45° FOV, posterior pole color fundus photograph, nonmydriatic — 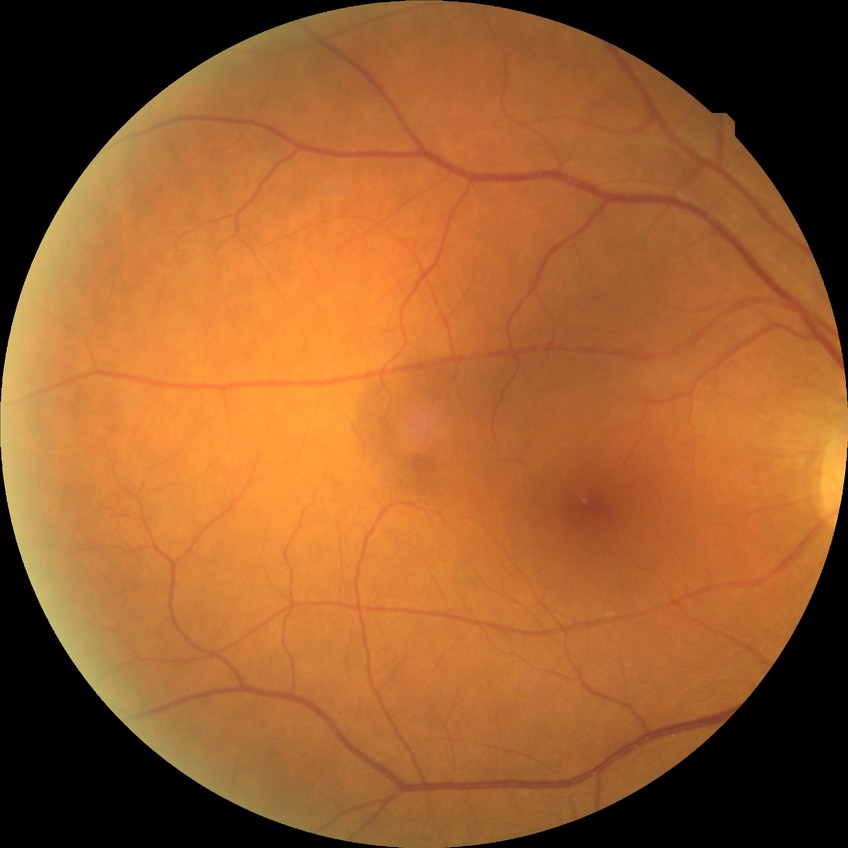 Diabetic retinopathy (DR): no diabetic retinopathy (NDR).